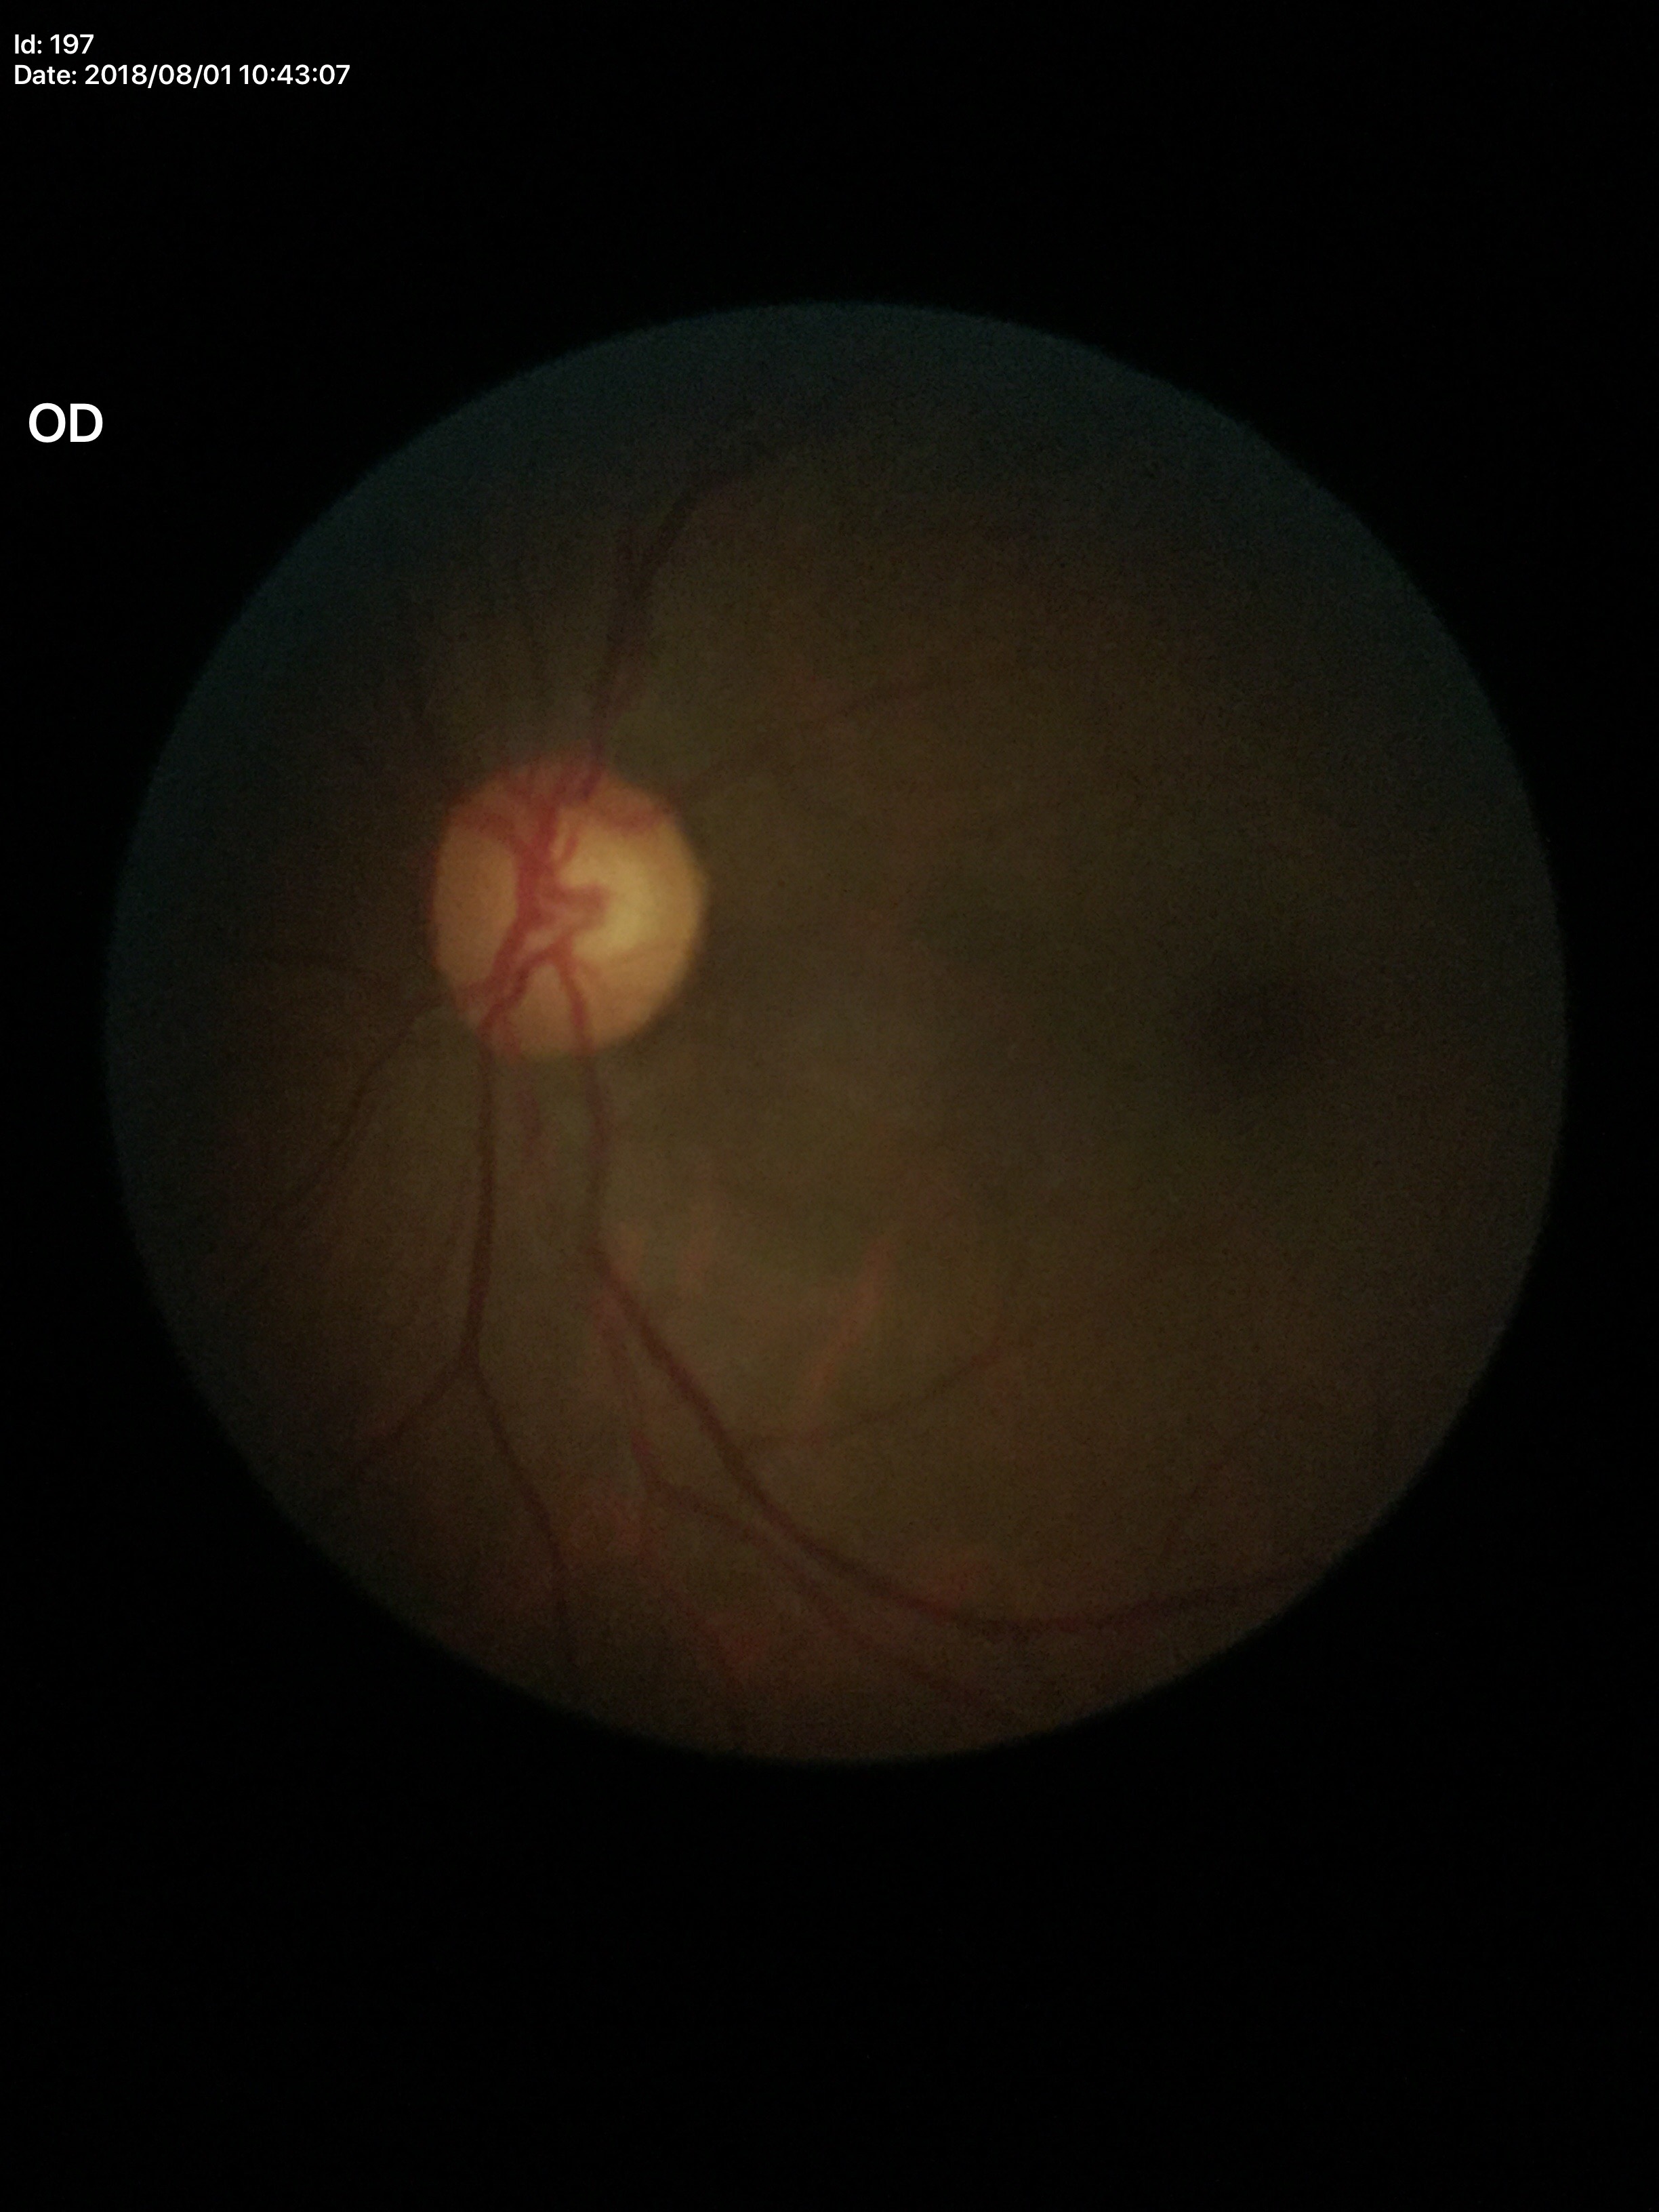
Annotations:
* Glaucoma impression · negative
* VCDR · 0.60